Infant wide-field fundus photograph.
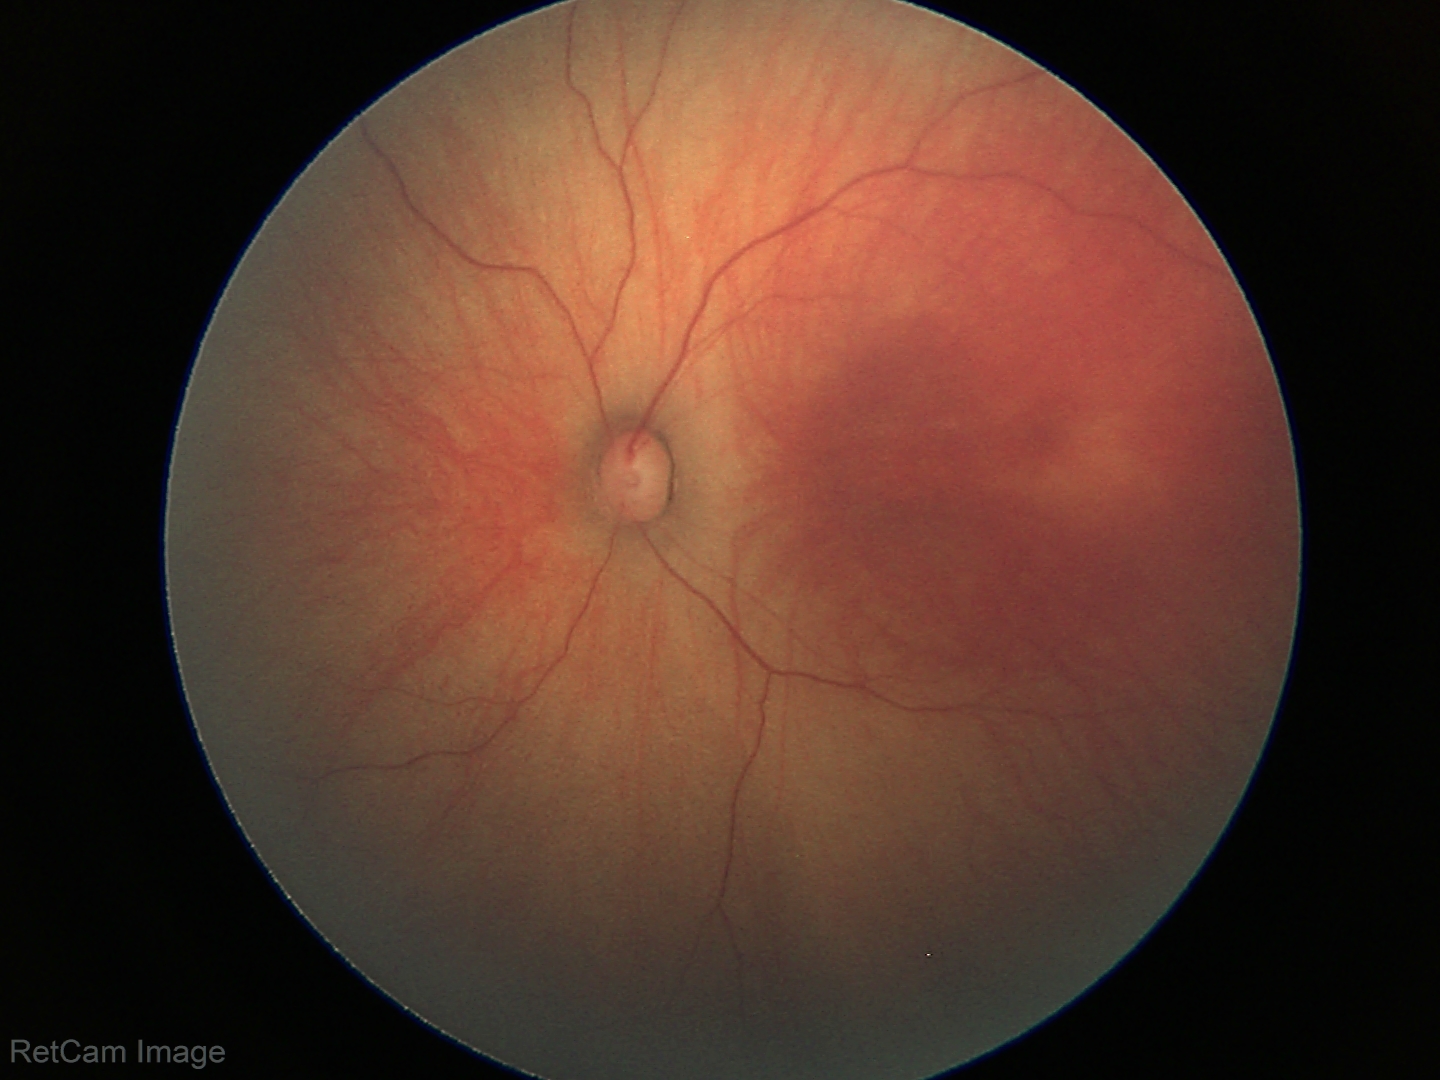
Screening examination with no abnormal retinal findings.